Color fundus photograph, no pharmacologic dilation, FOV: 45 degrees:
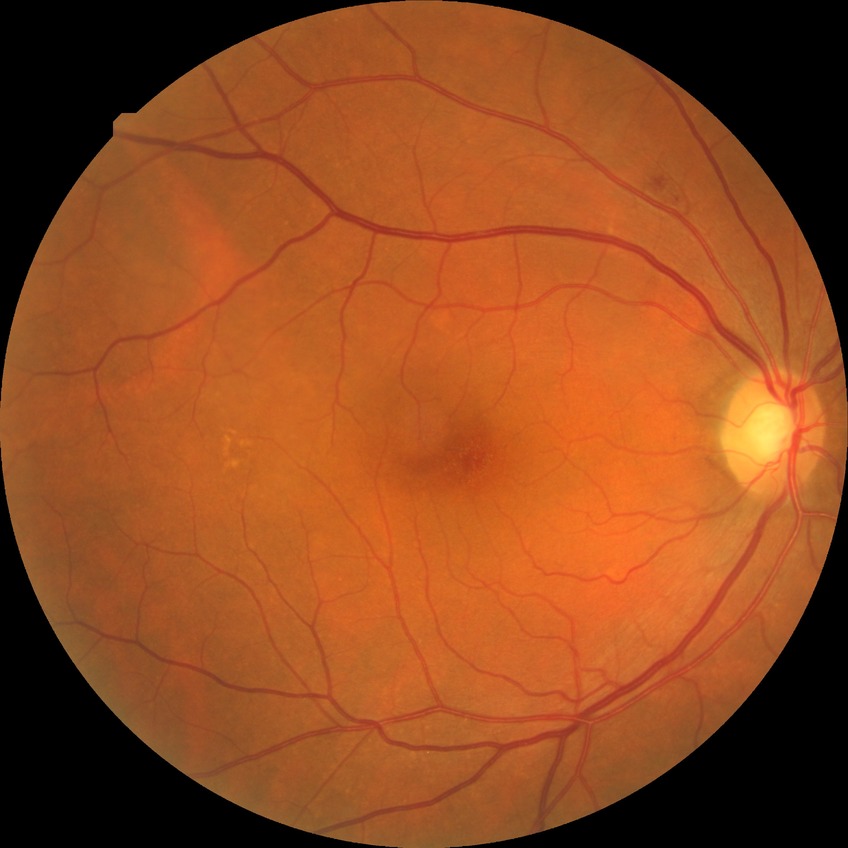

Modified Davis classification is no diabetic retinopathy.